Retinal fundus photograph; 2352 x 1568 pixels; 45° field of view.
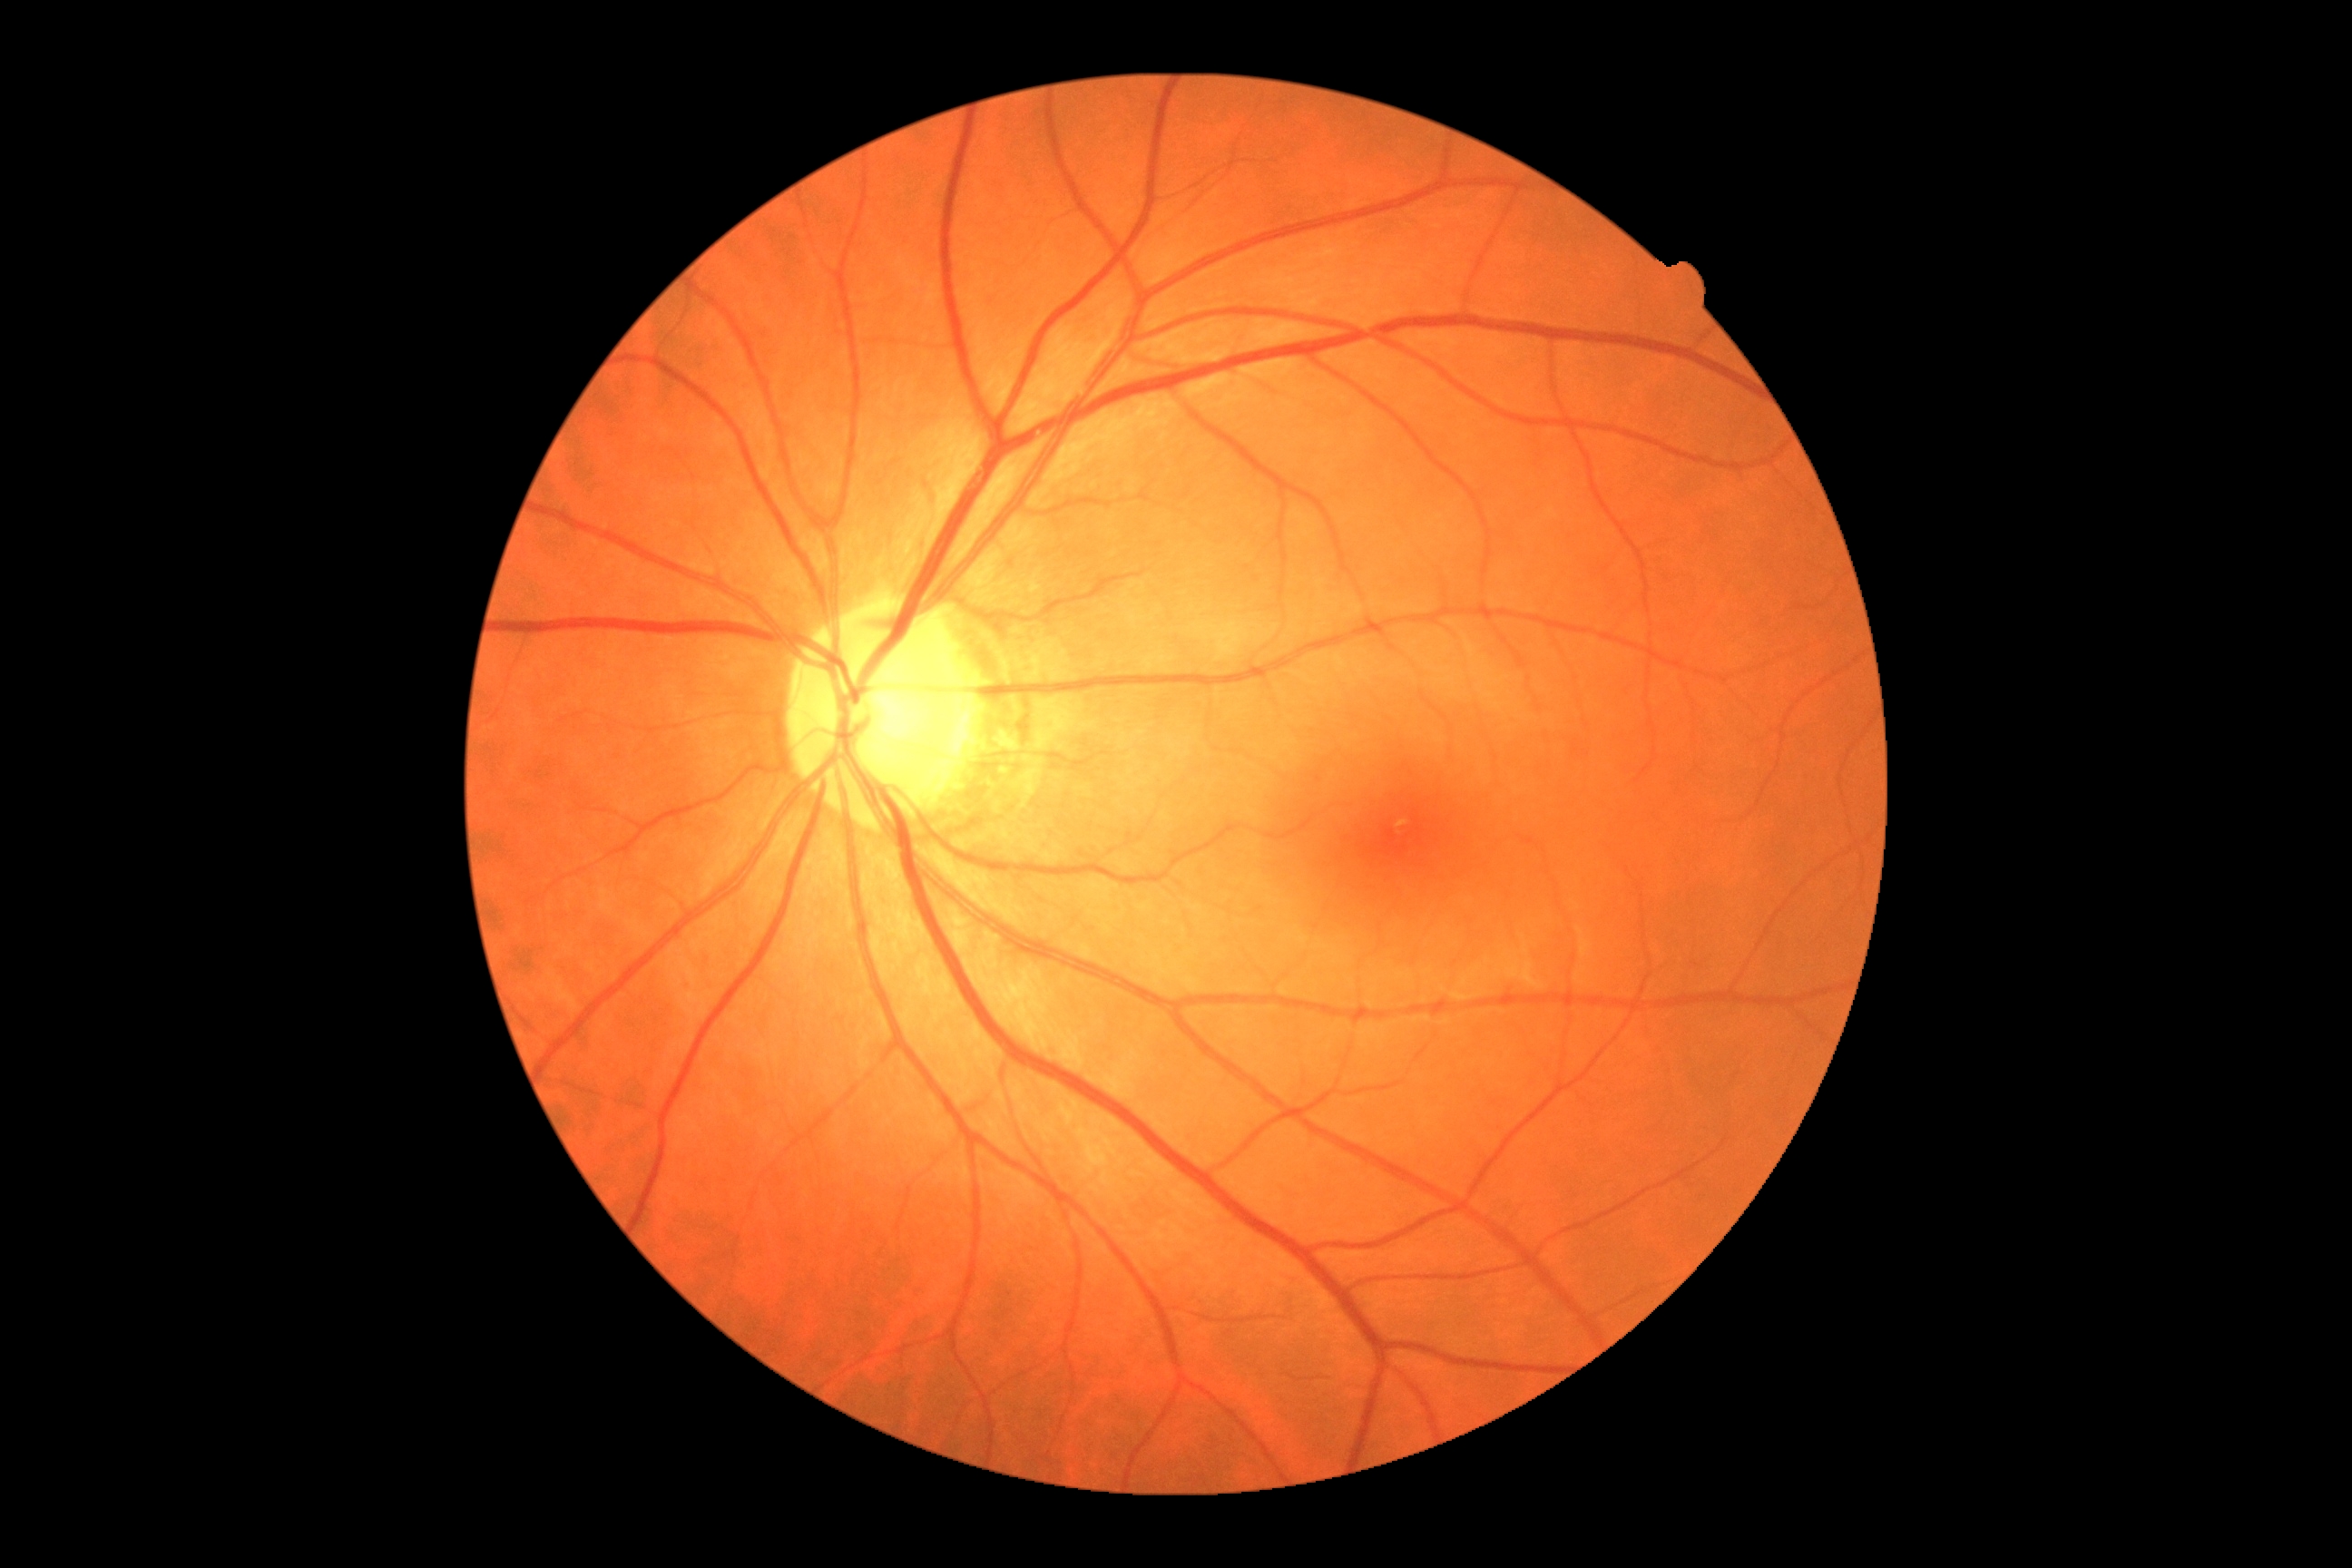

Diabetic retinopathy: 0/4 — no visible signs of diabetic retinopathy. No DR findings.